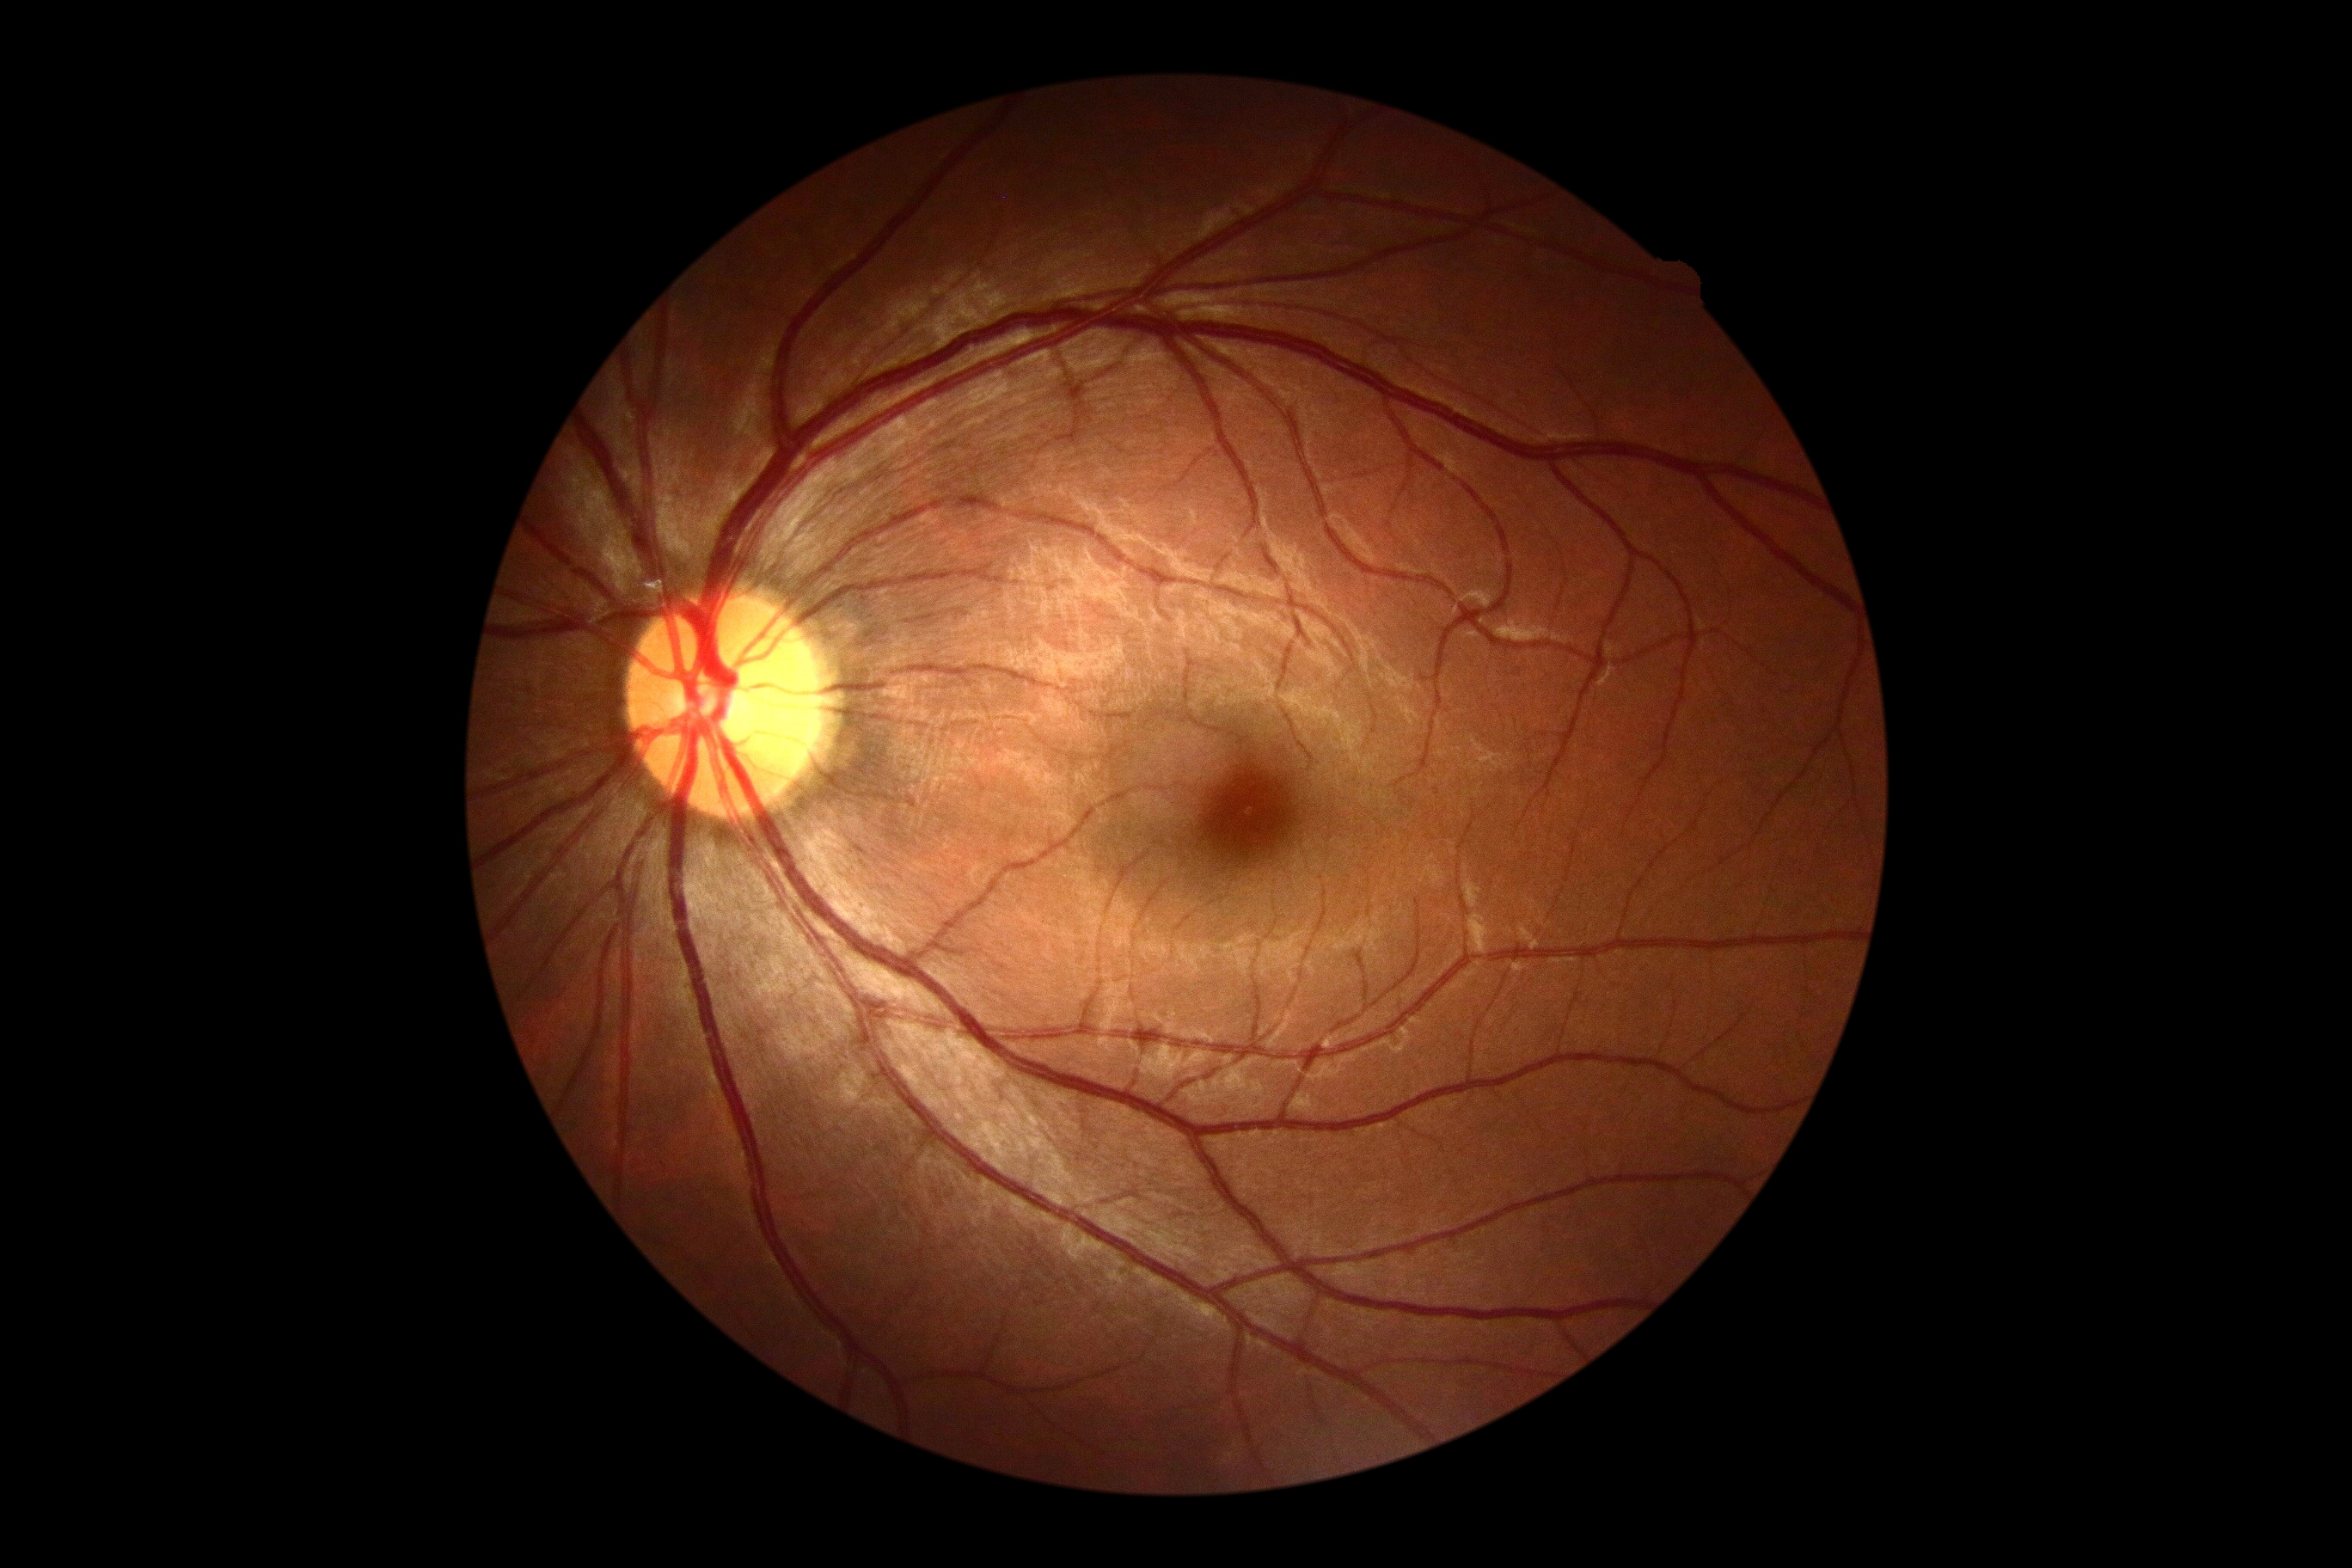
DR severity: no apparent diabetic retinopathy (grade 0).
No apparent diabetic retinopathy.